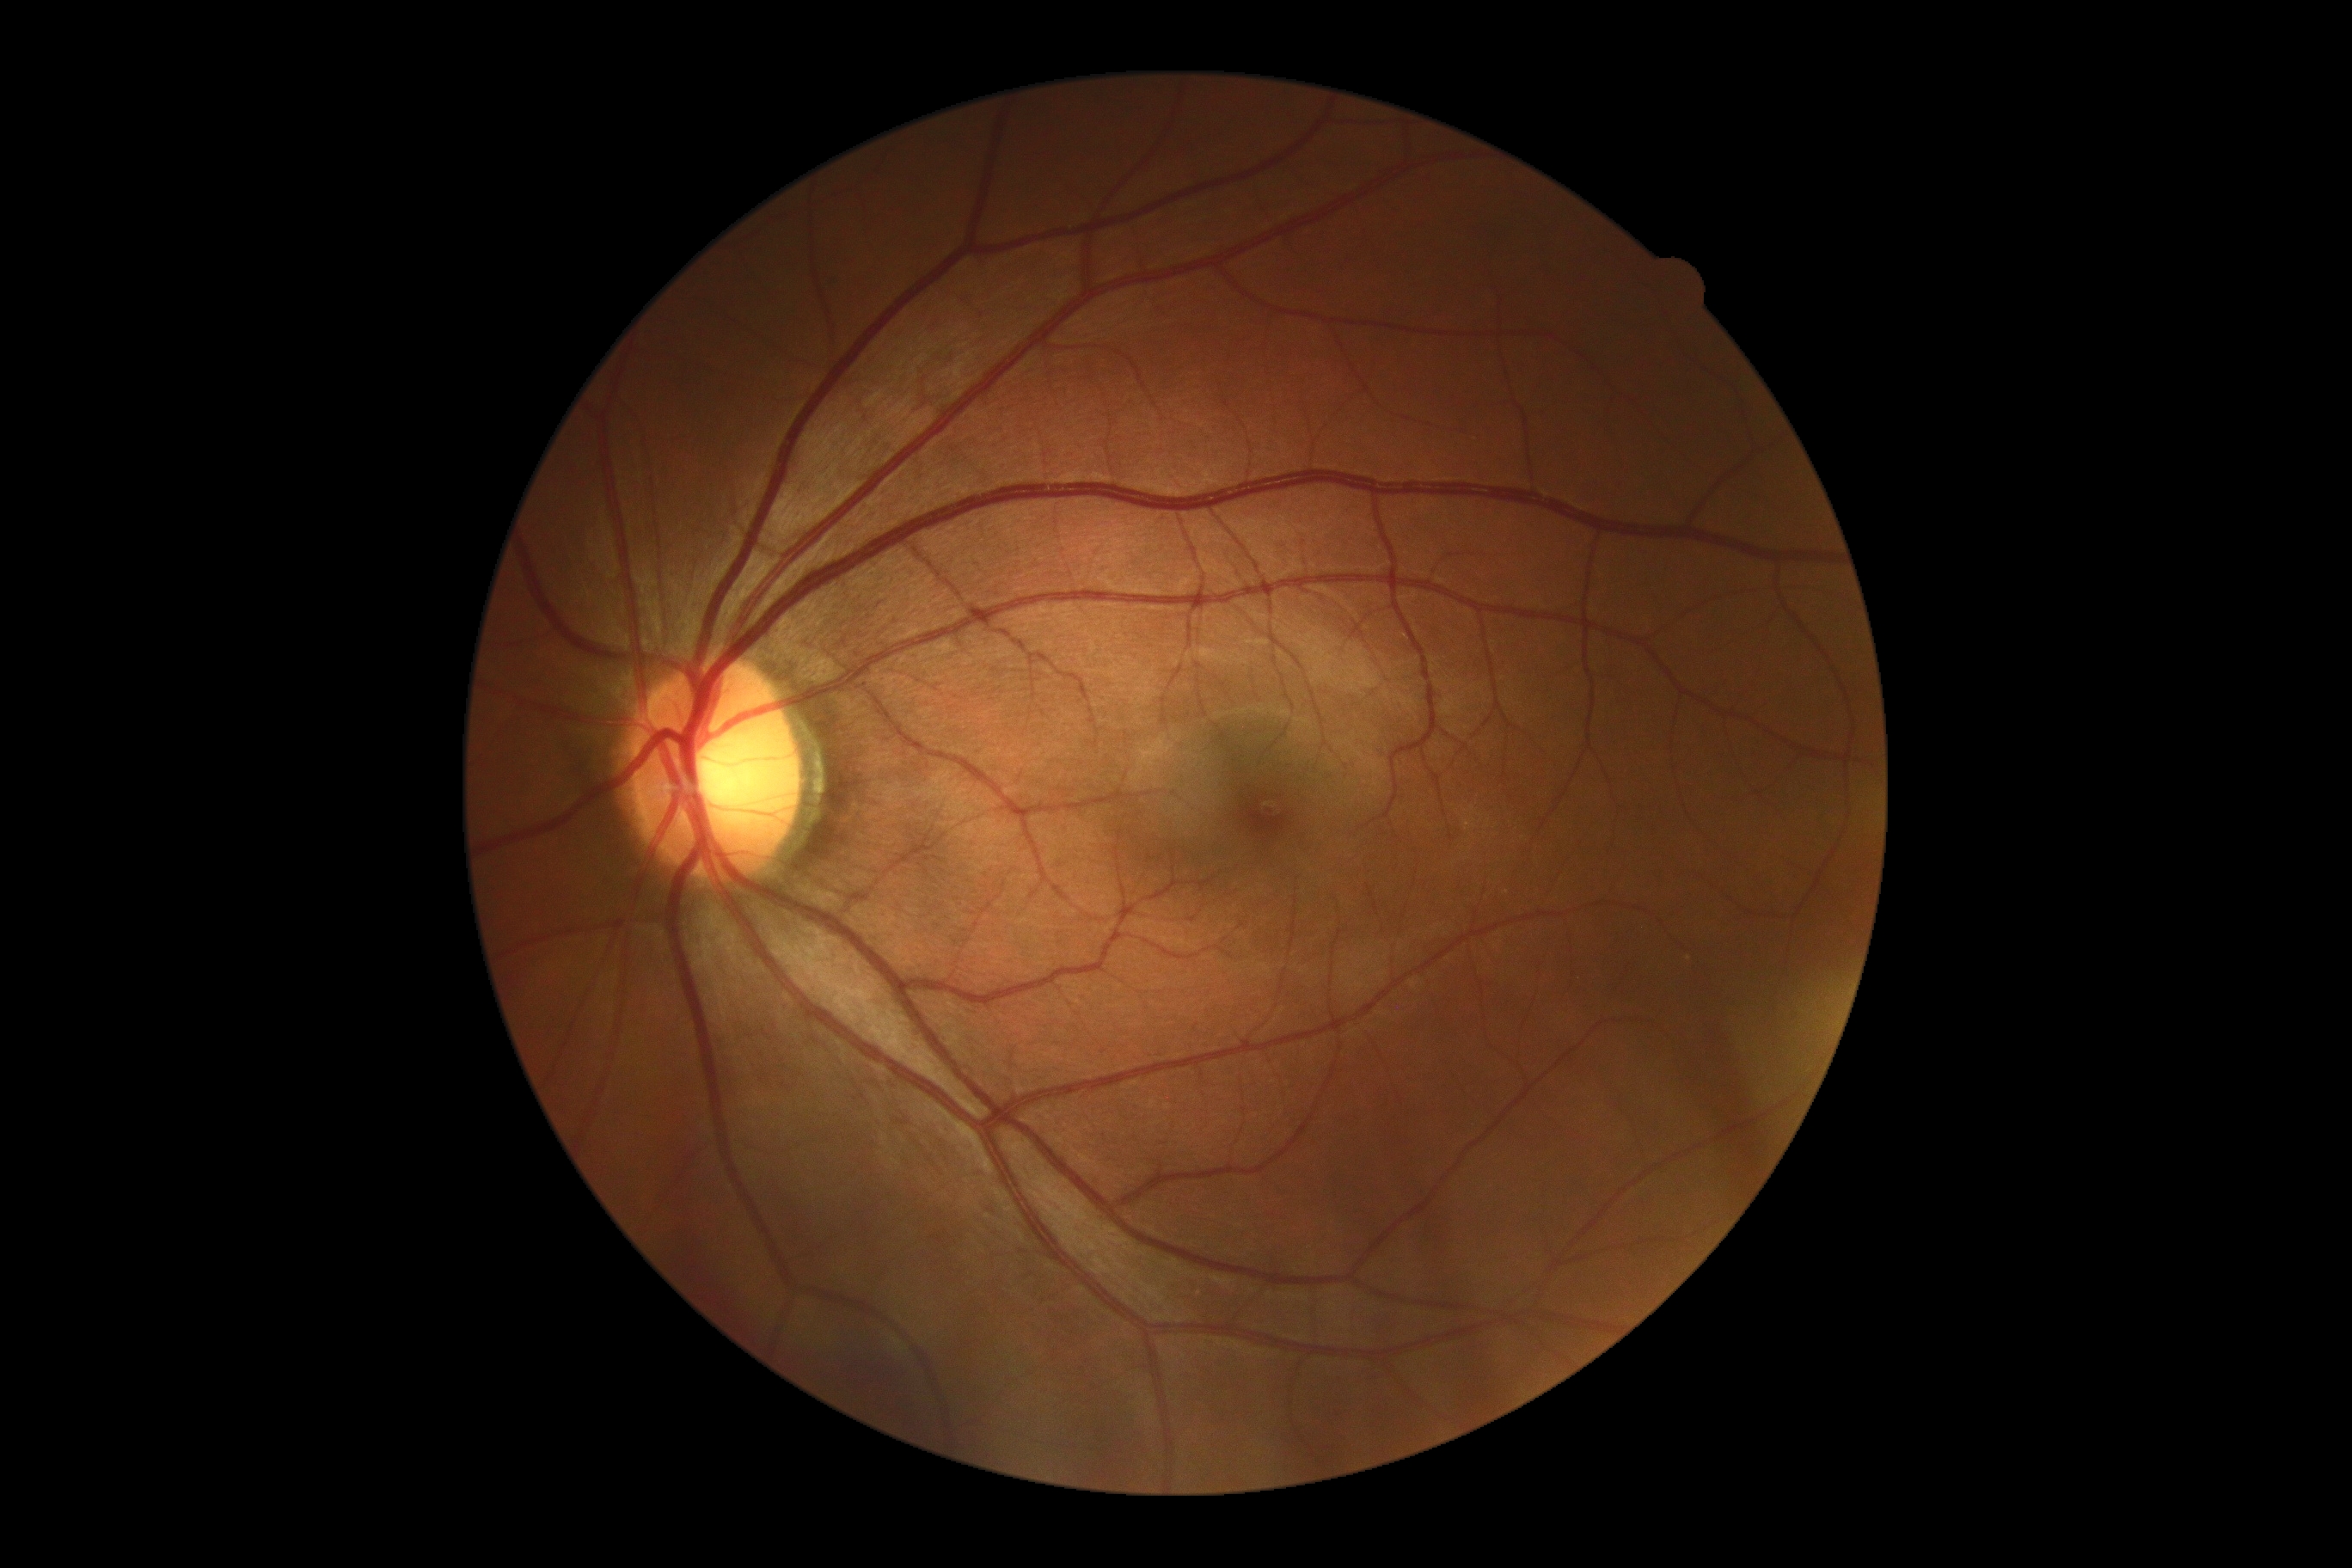

Diabetic retinopathy (DR) is 0/4.
No diabetic retinal disease findings.